Macula-centered, 1932 by 1932 pixels, 50-degree field of view.
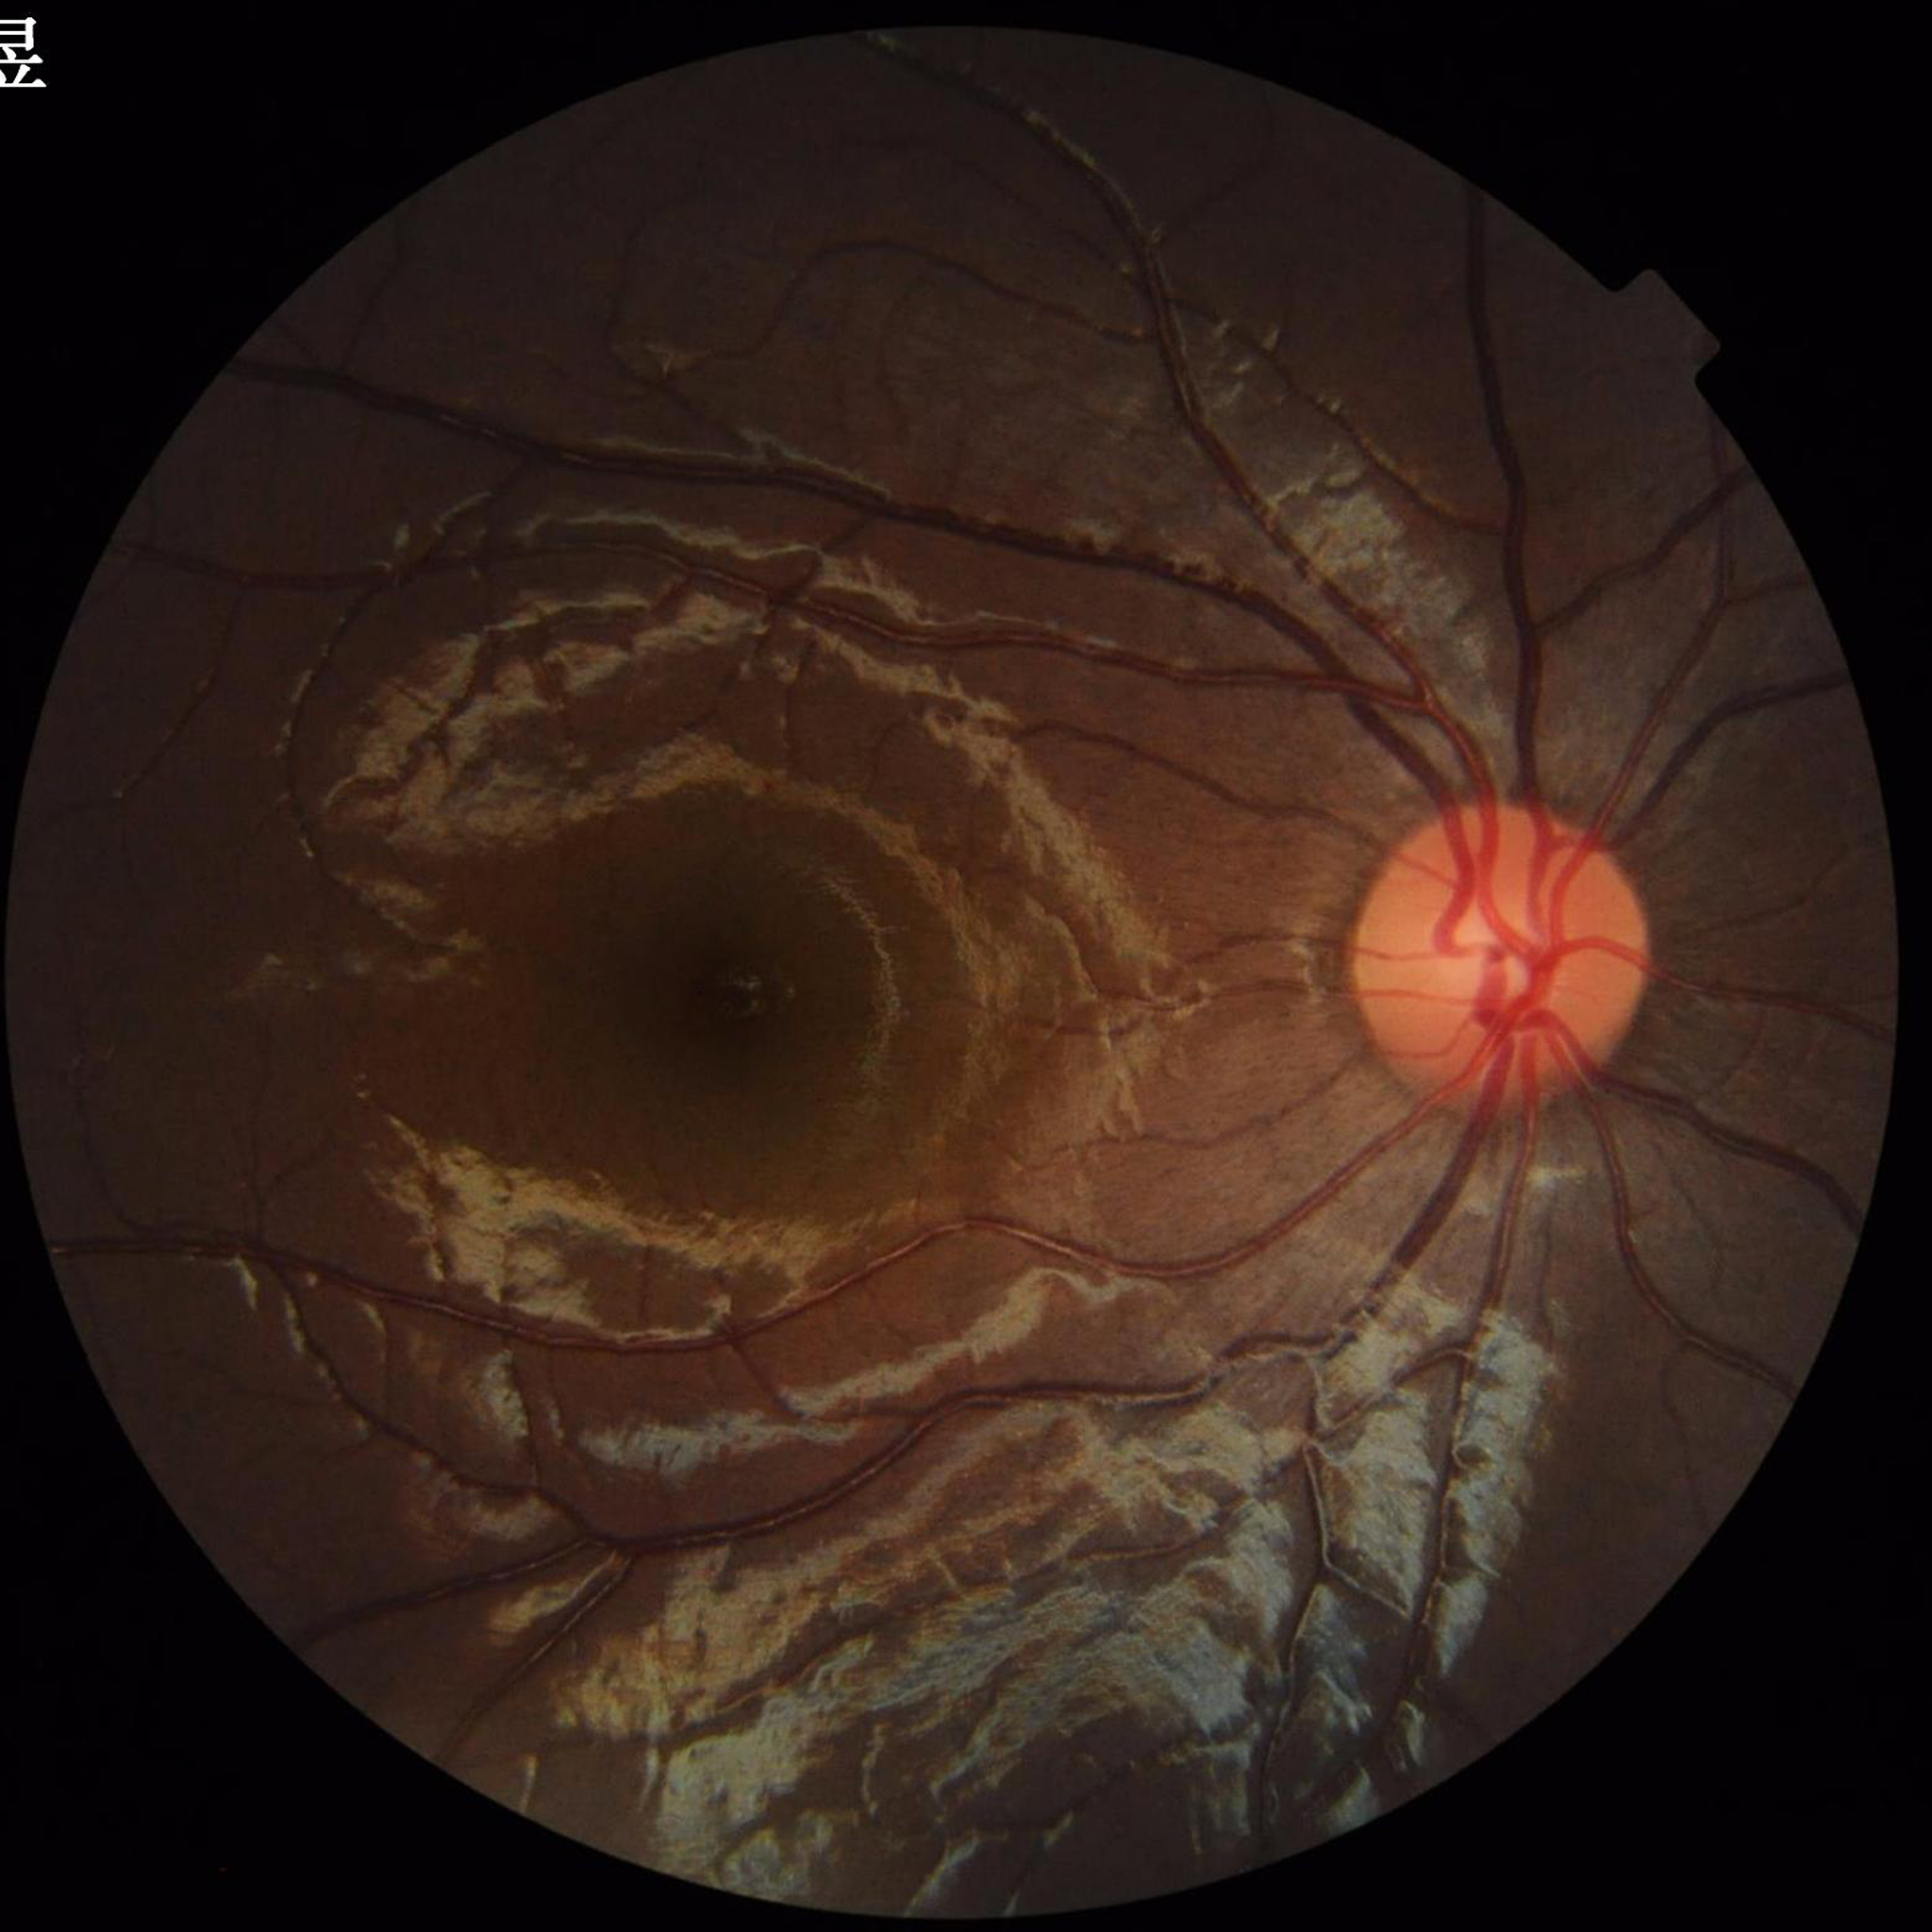 Retinal fundus photograph from a control without AMD, DR, or glaucoma. Quality: good.